2352x1568px — 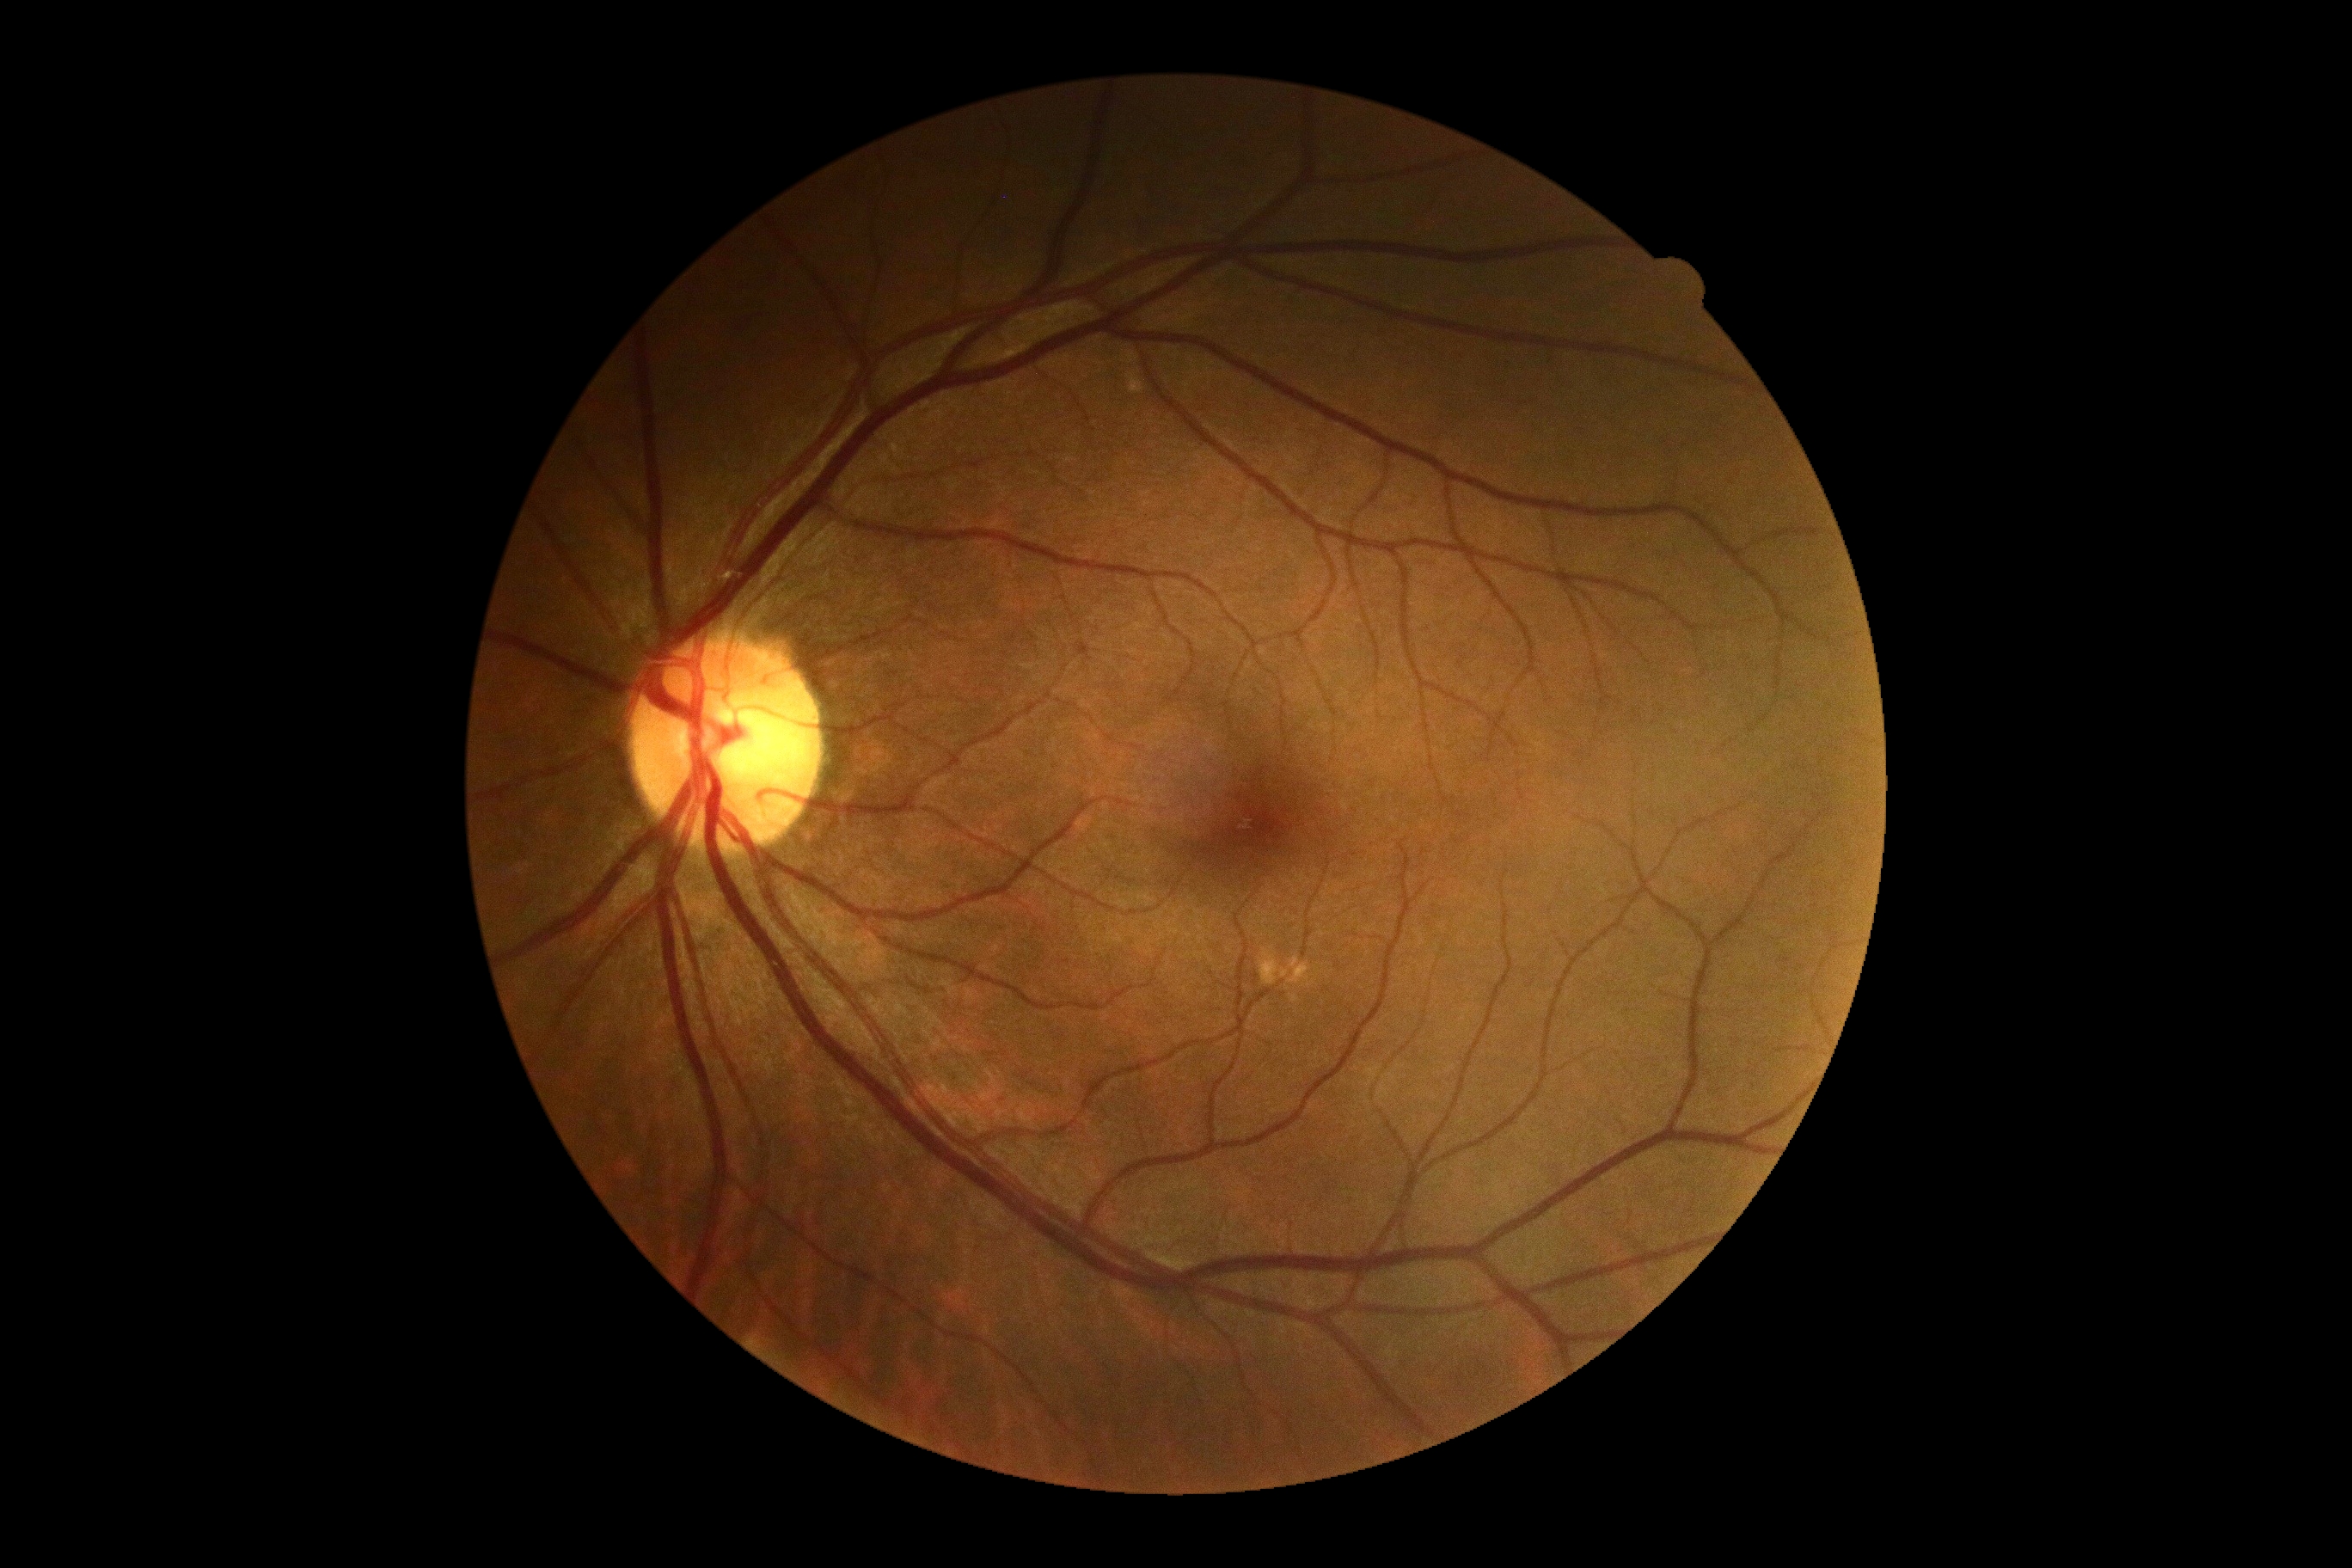

DR grade is 0.
No diabetic retinal disease findings.